45° field of view: 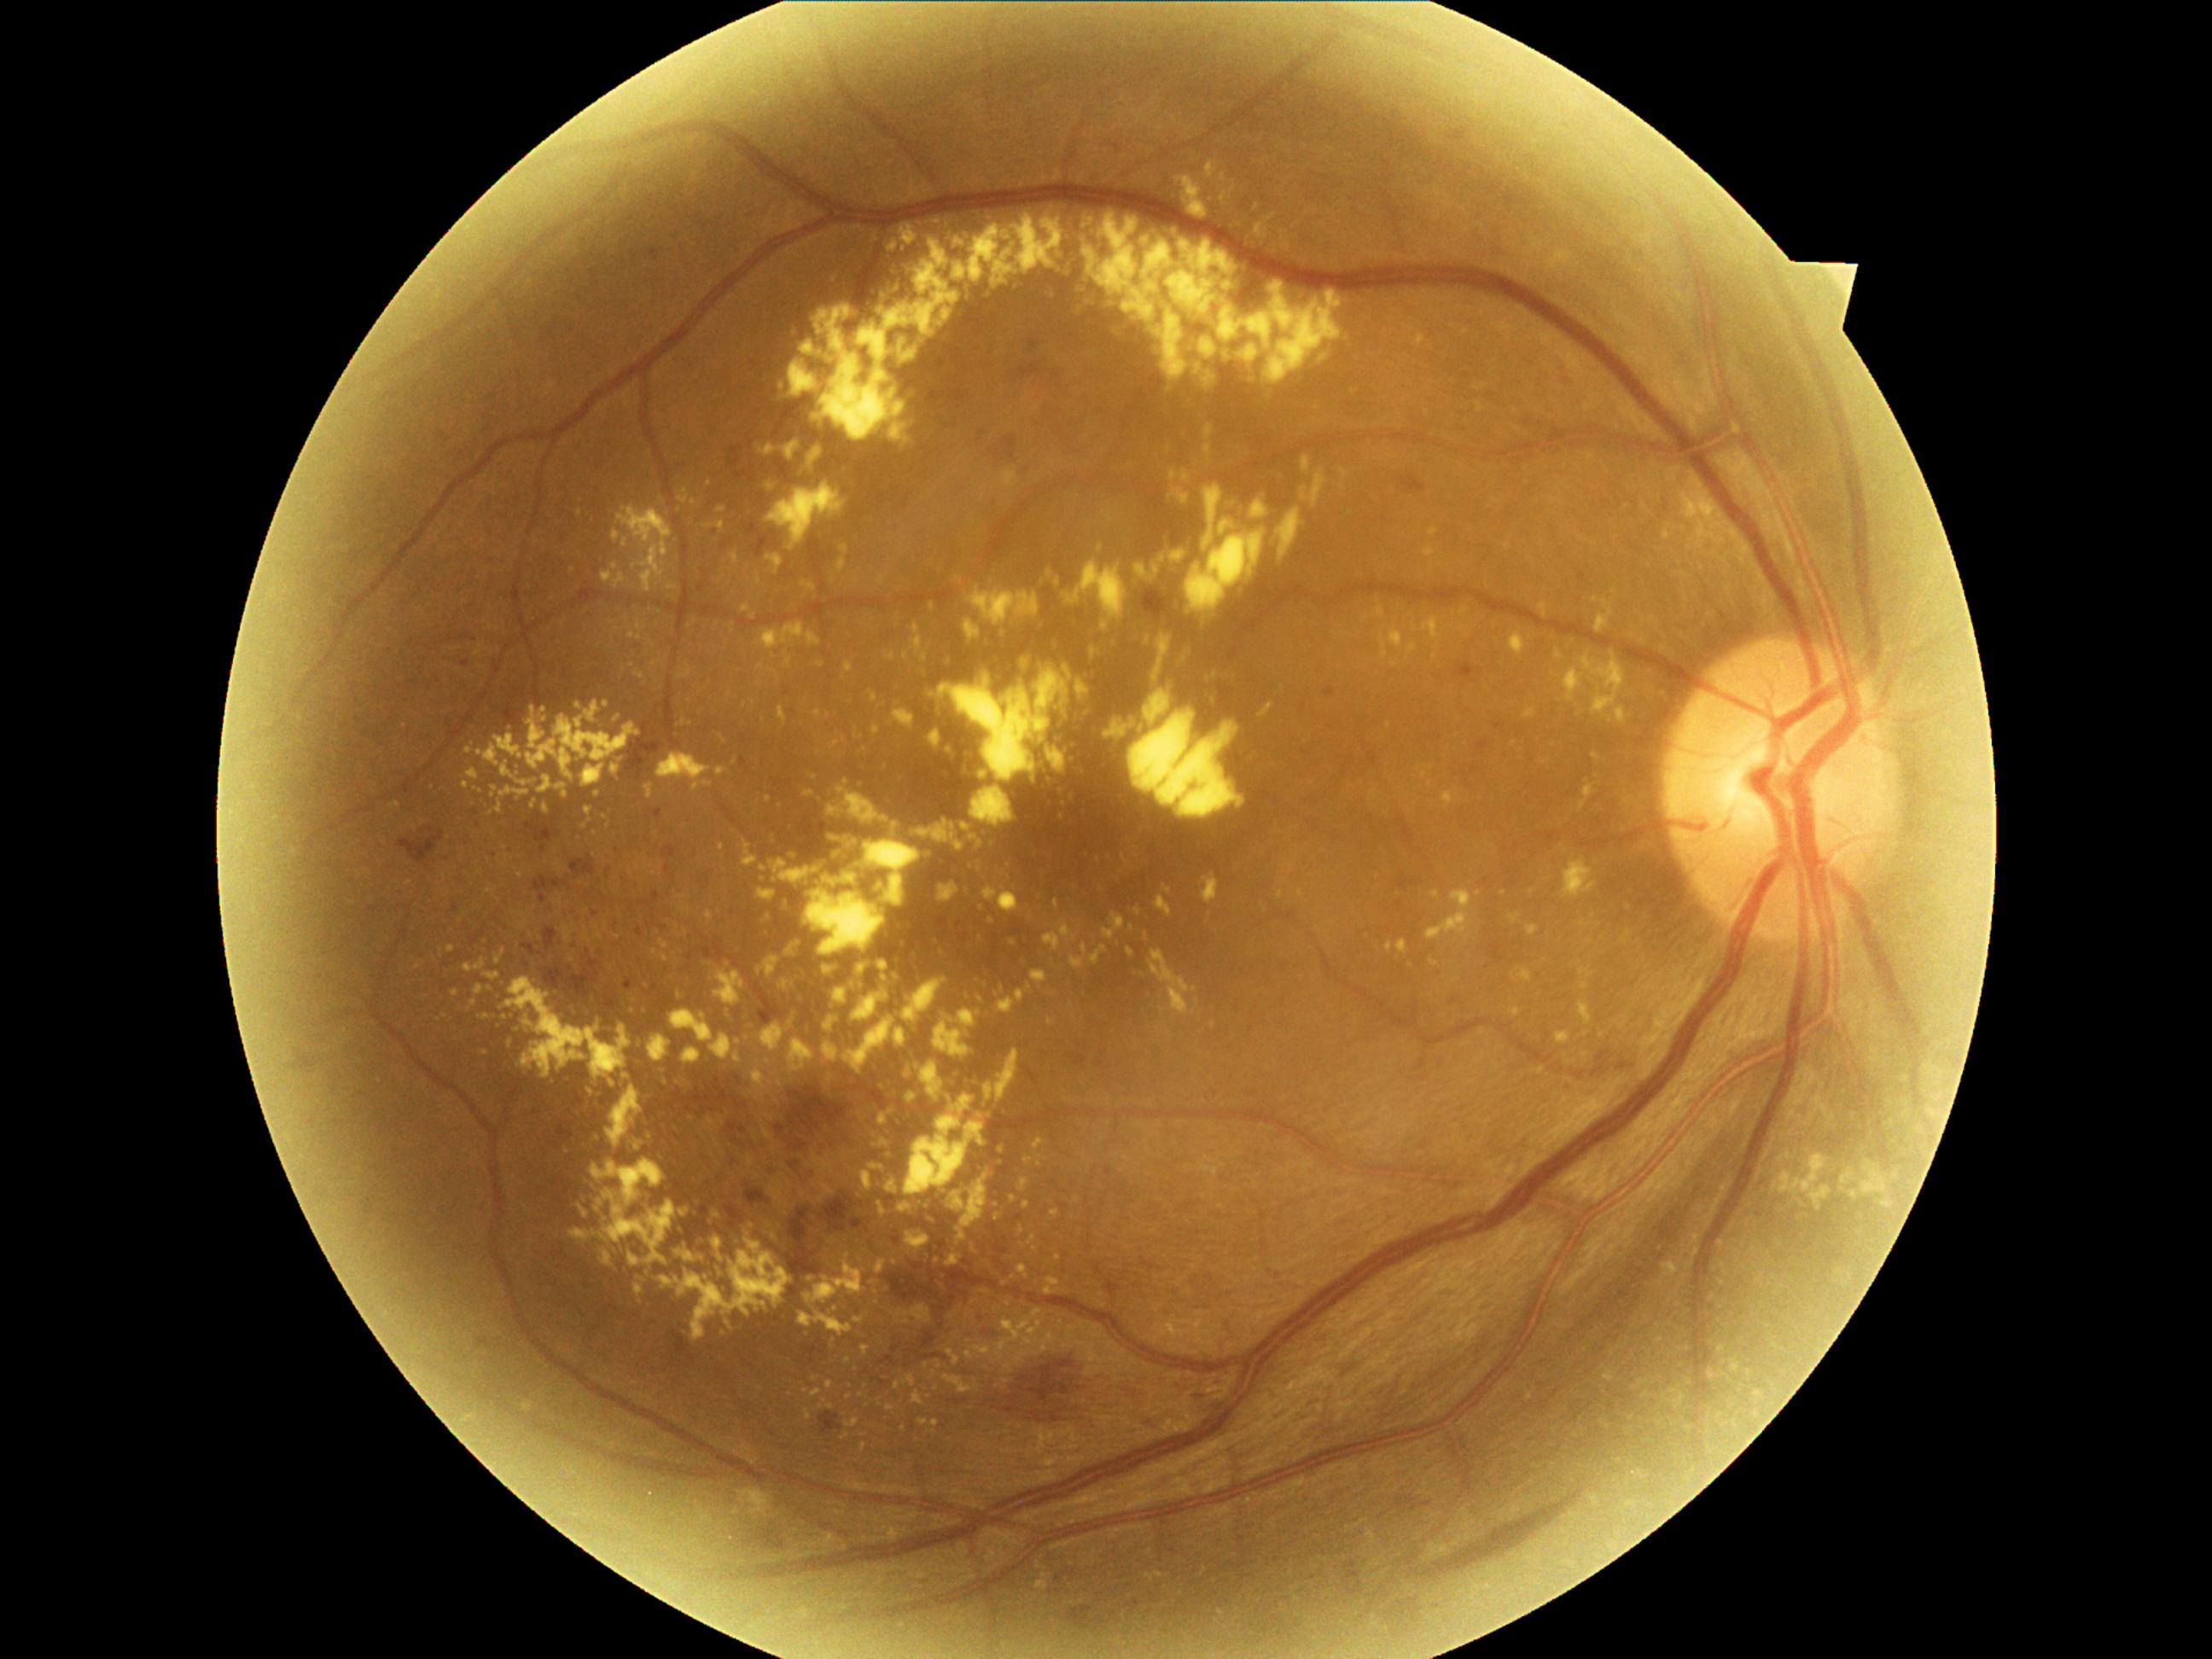

dr_grade: moderate non-proliferative diabetic retinopathy (grade 2)